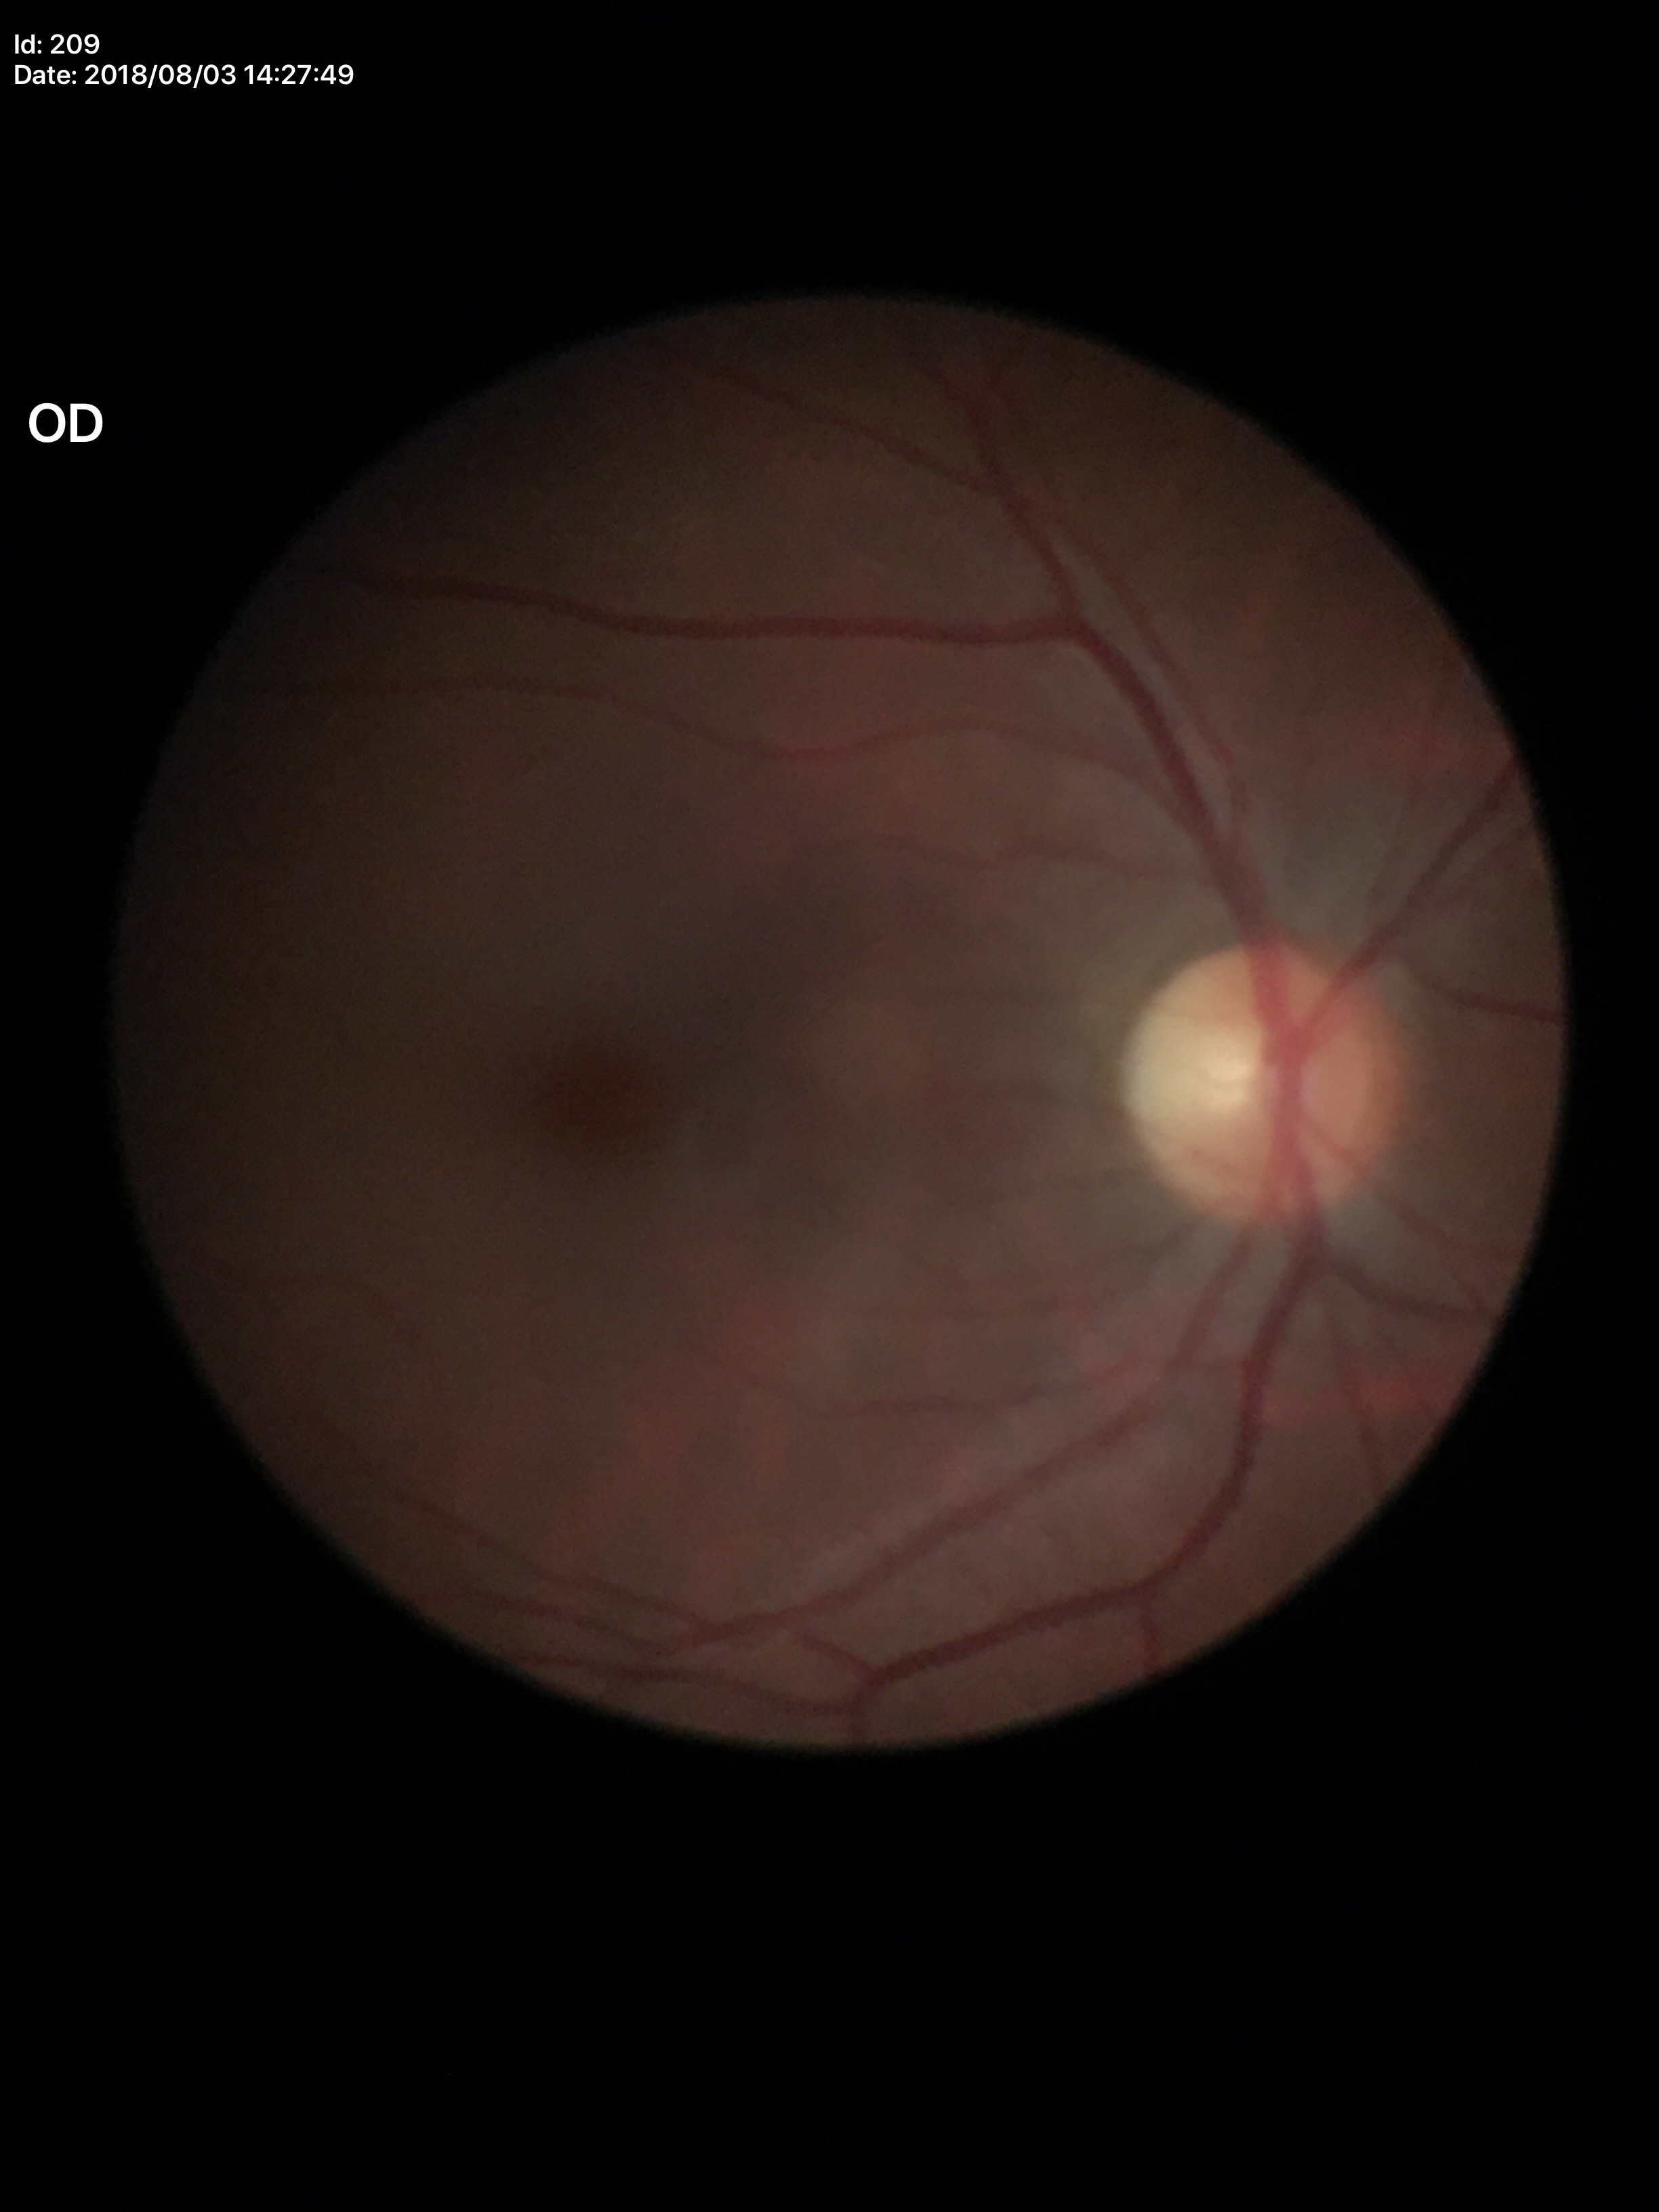

Glaucoma assessment: negative | vertical C/D ratio: 0.45 | area cup-disc ratio: 0.20